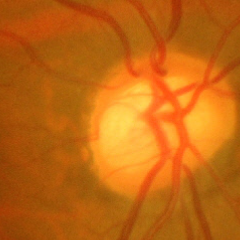

Q: What is the glaucoma diagnosis?
A: Yes — advanced-stage glaucoma.